Camera: Phoenix ICON (100° FOV) · 1240 by 1240 pixels · wide-field fundus photograph of an infant
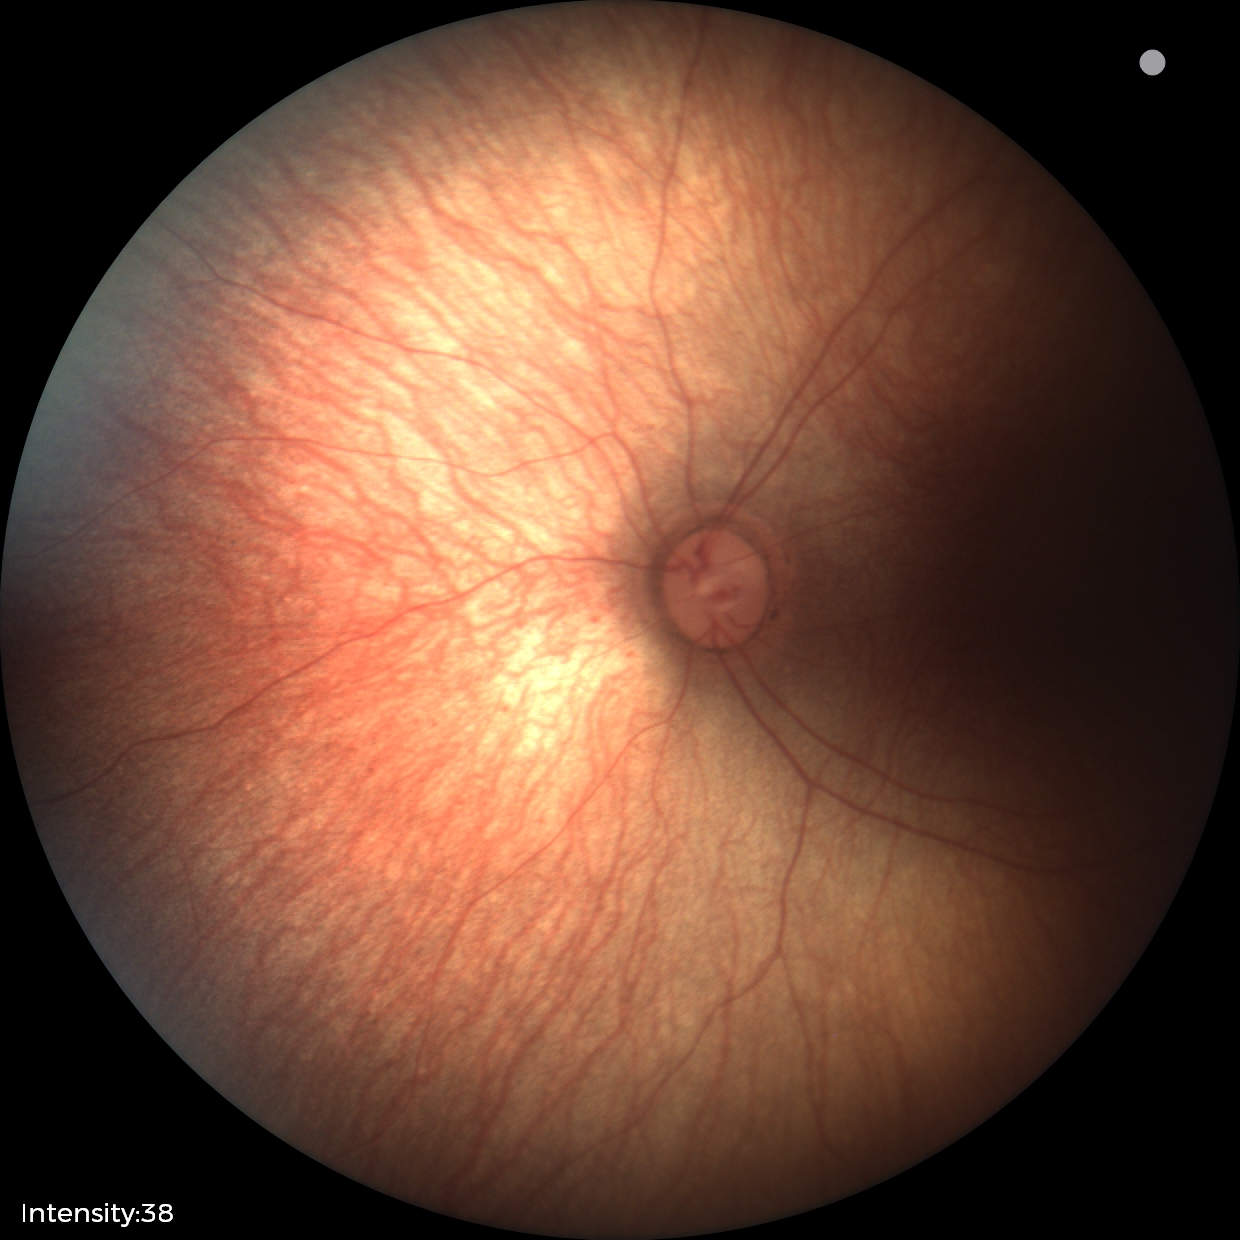 Screening examination with no abnormal retinal findings.